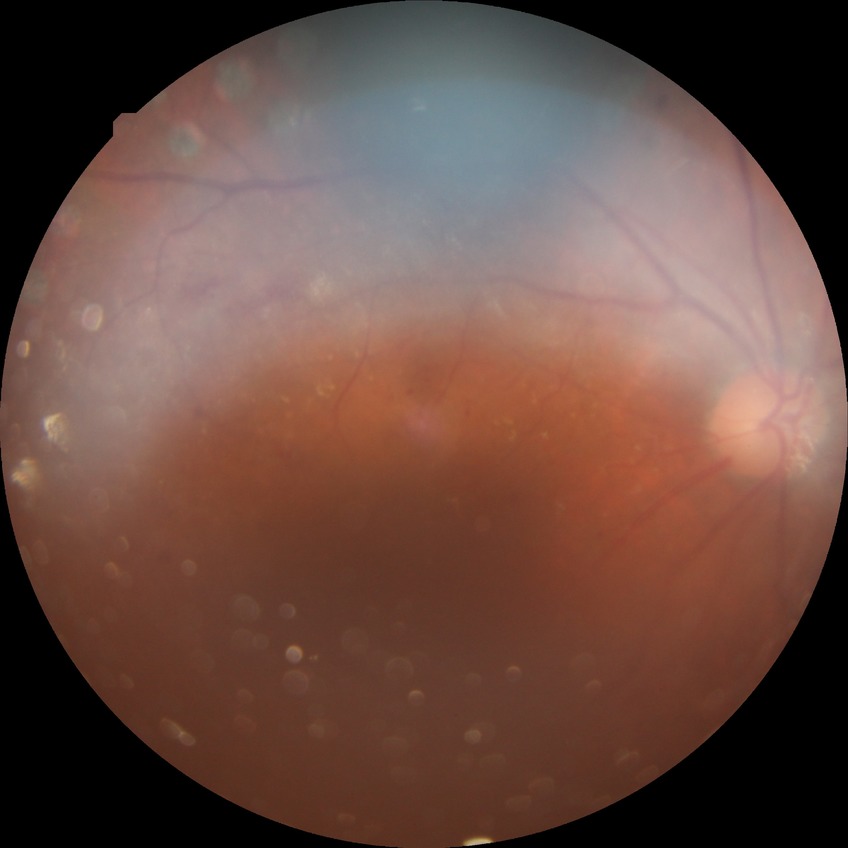 Diabetic retinopathy grade: proliferative diabetic retinopathy.